Diabetic retinopathy graded by the modified Davis classification, 848x848
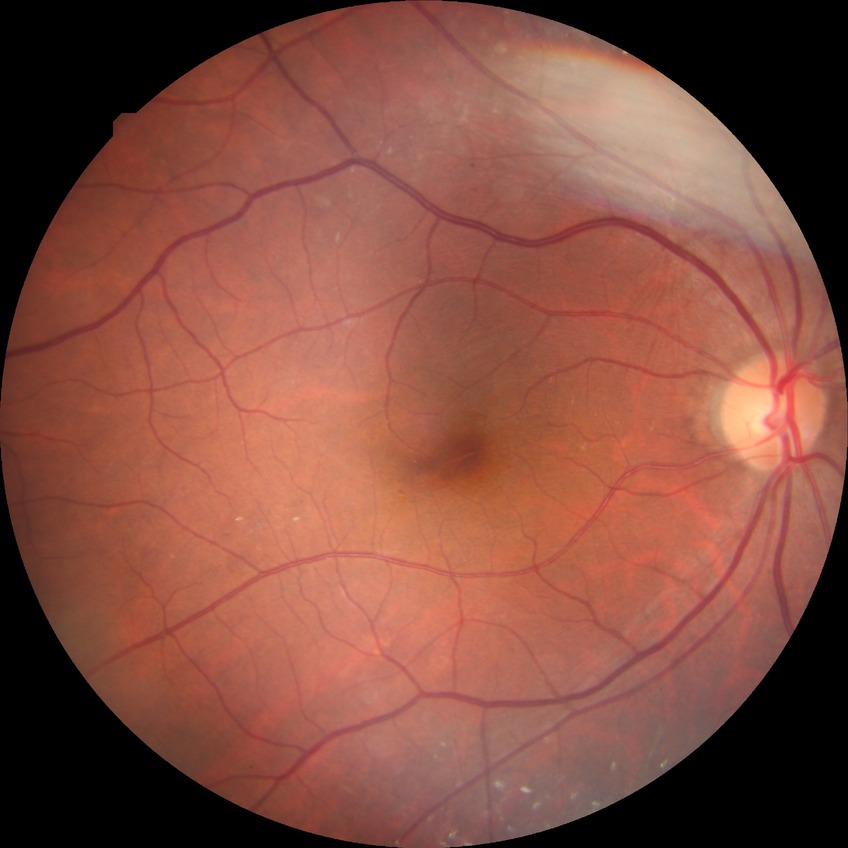 Diabetic retinopathy (DR) is simple diabetic retinopathy (SDR).